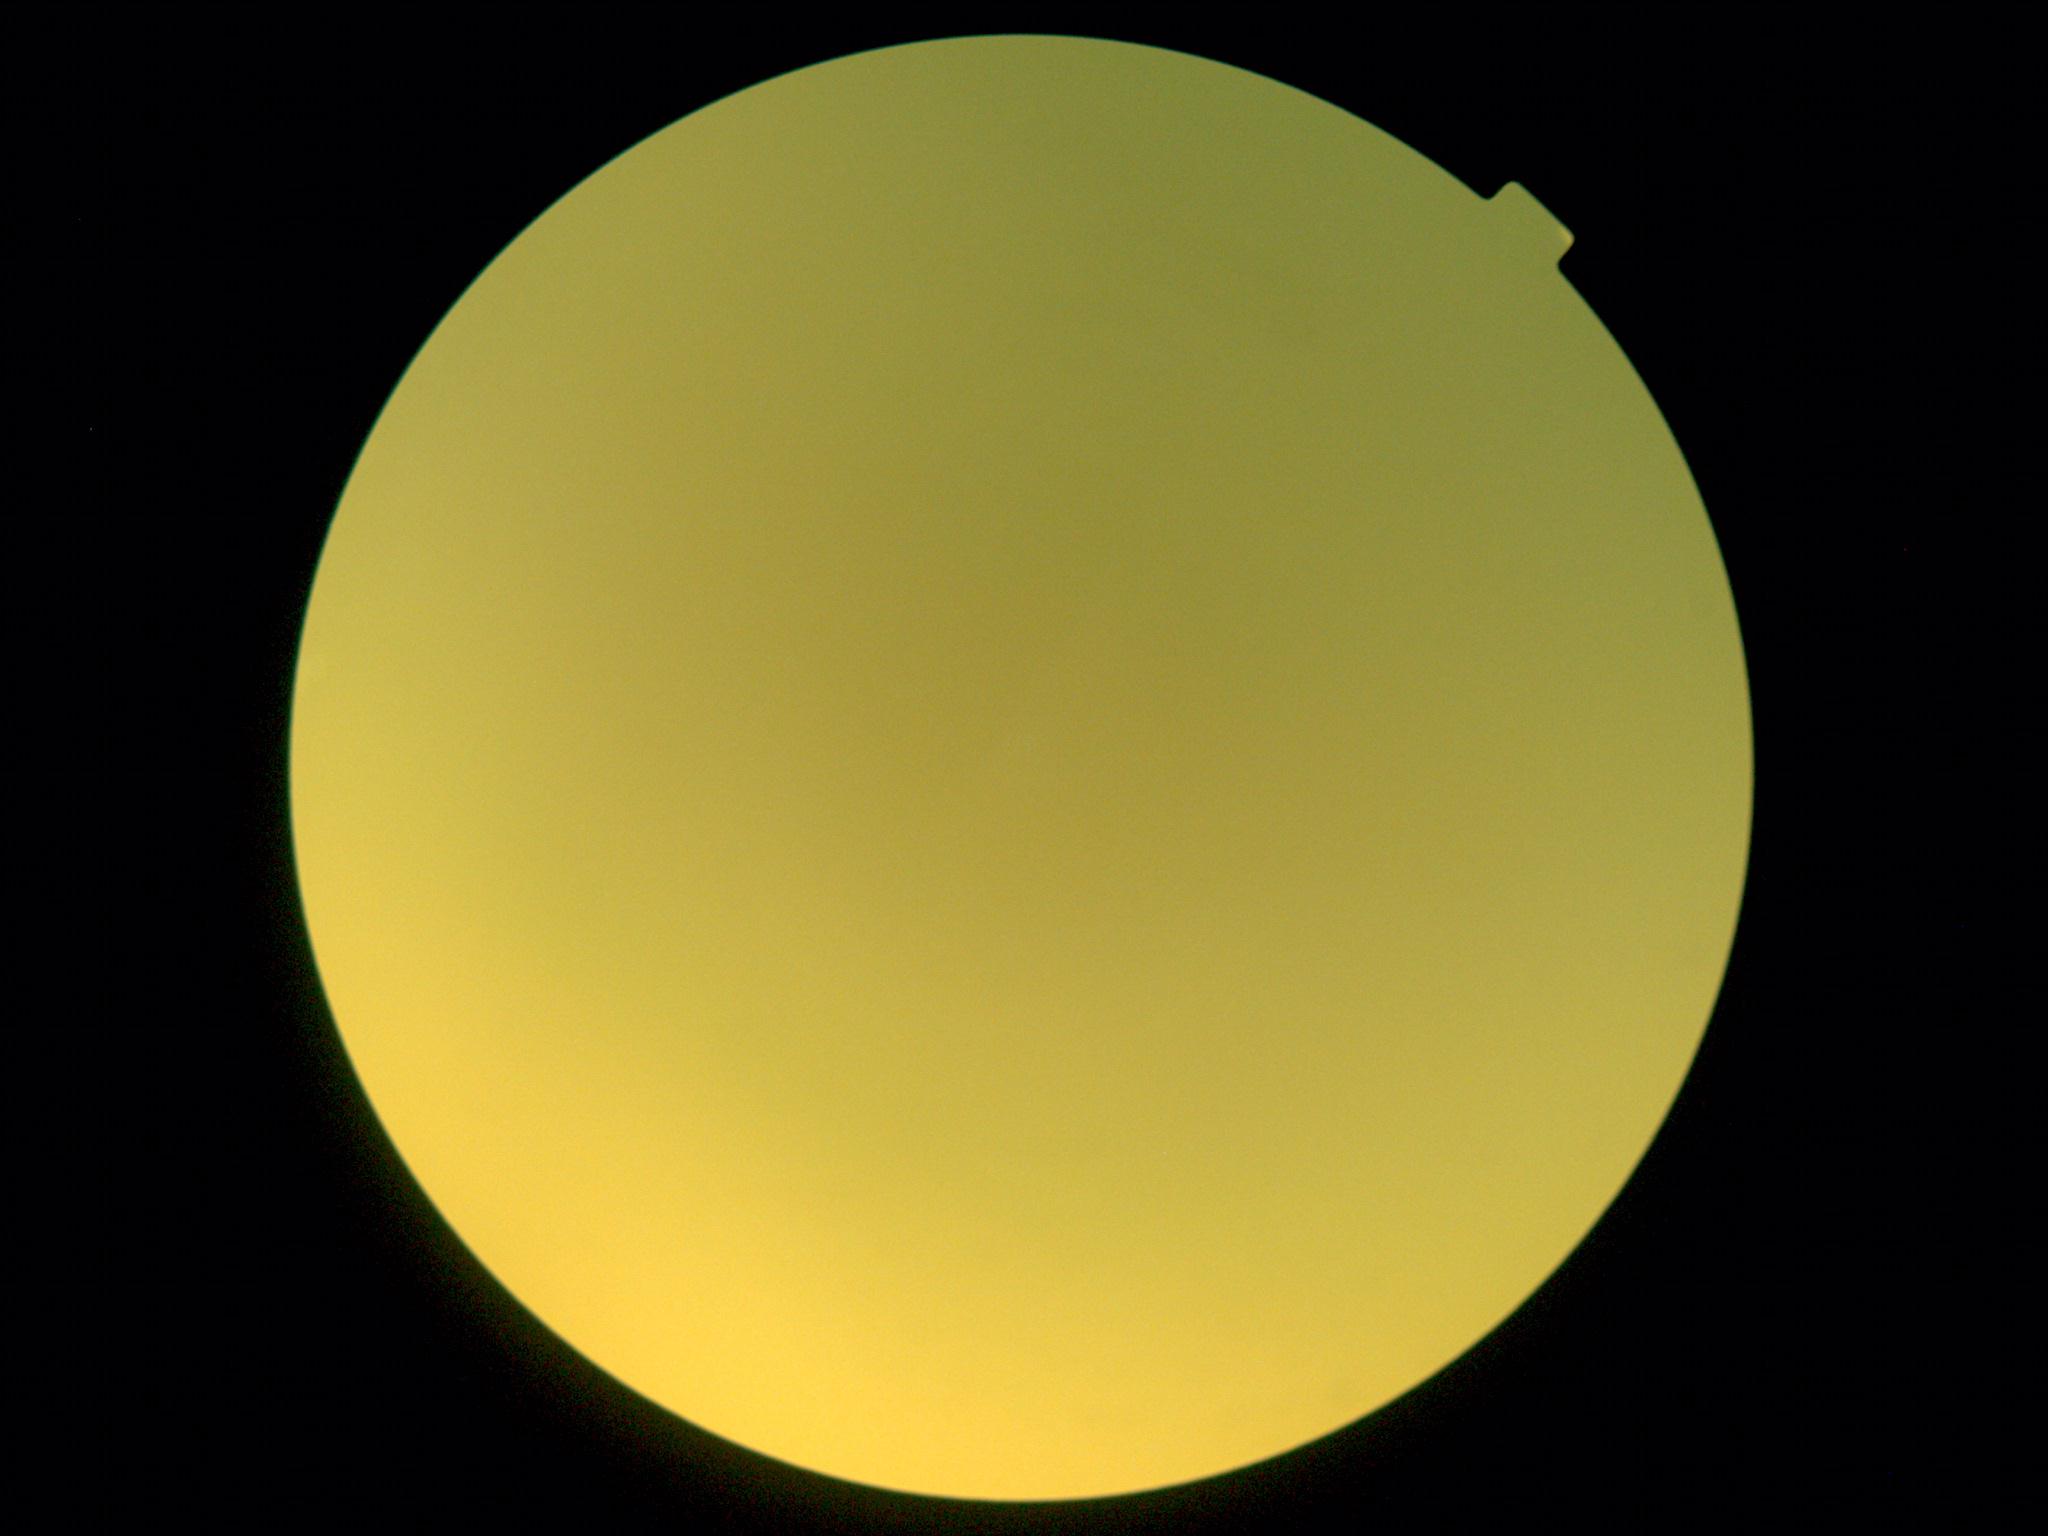
The image cannot be graded for diabetic retinopathy. DR grade: ungradable.